45° field of view · camera: NIDEK AFC-230 · DR severity per modified Davis staging: 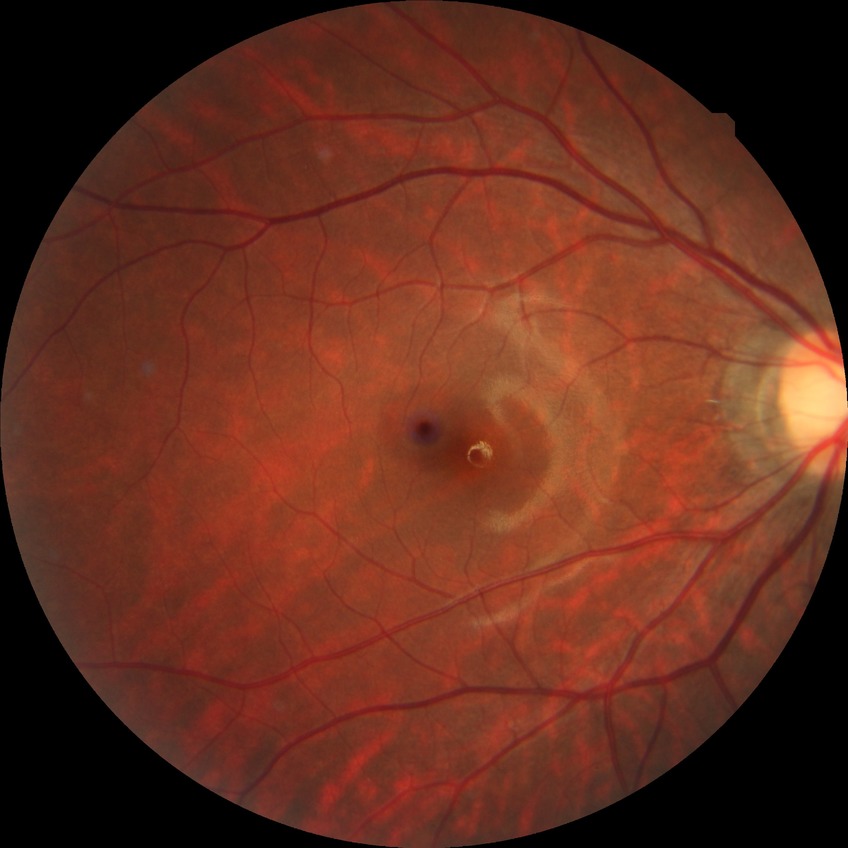
Modified Davis grading: no diabetic retinopathy.